DR severity per modified Davis staging · nonmydriatic fundus photograph — 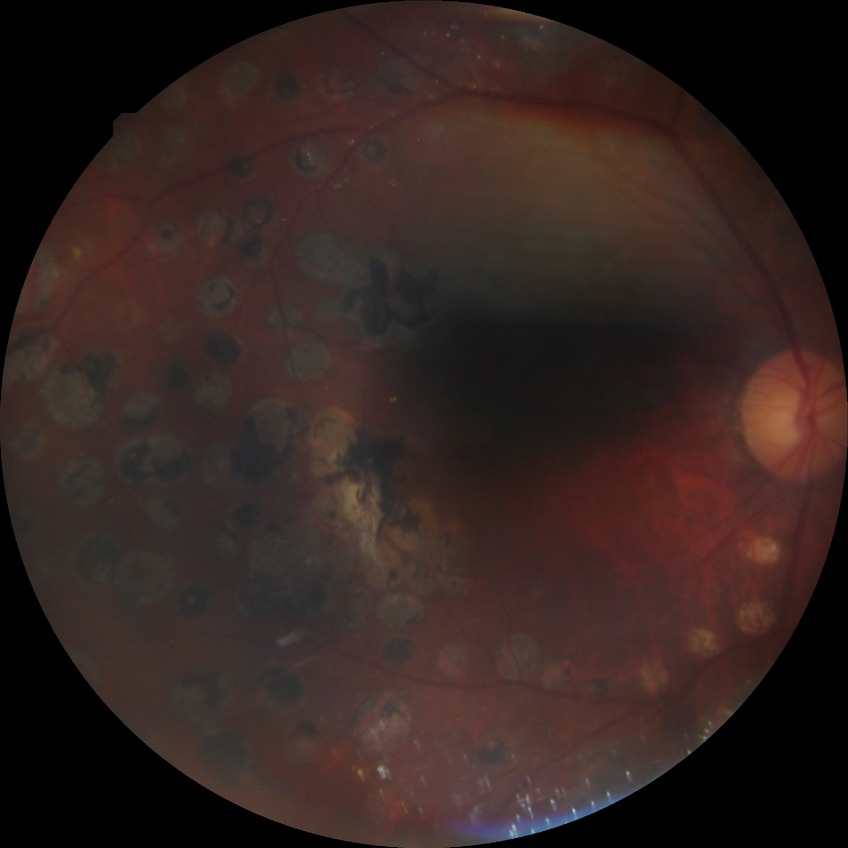 Assessment:
– Davis grading: proliferative diabetic retinopathy